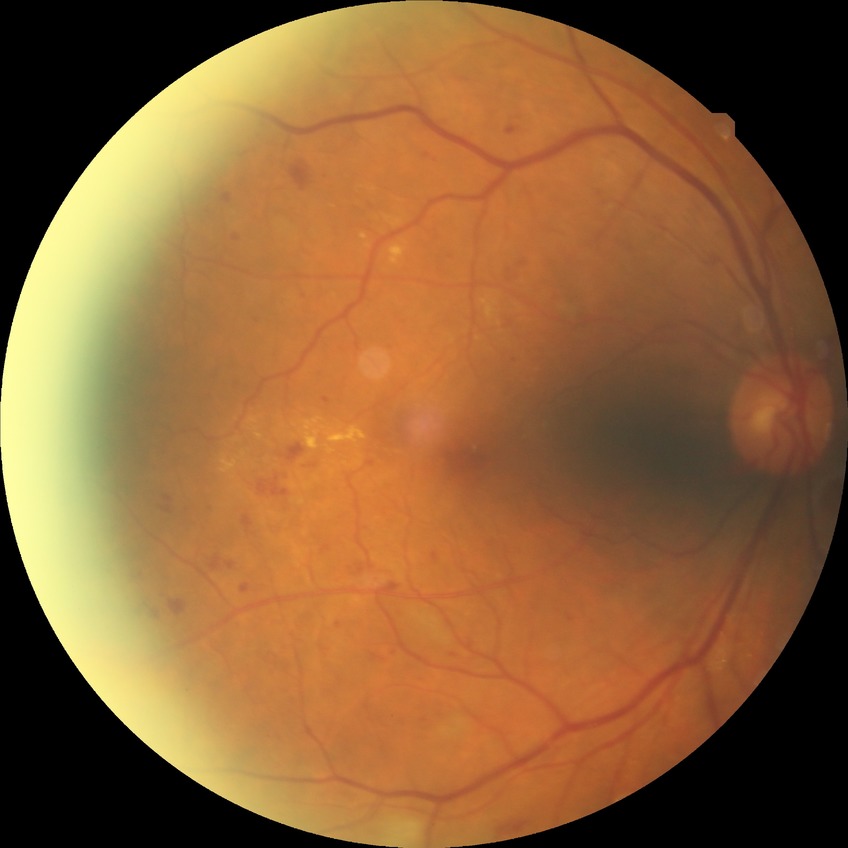 Diabetic retinopathy (DR): PPDR (pre-proliferative diabetic retinopathy).